Pediatric retinal photograph (wide-field): 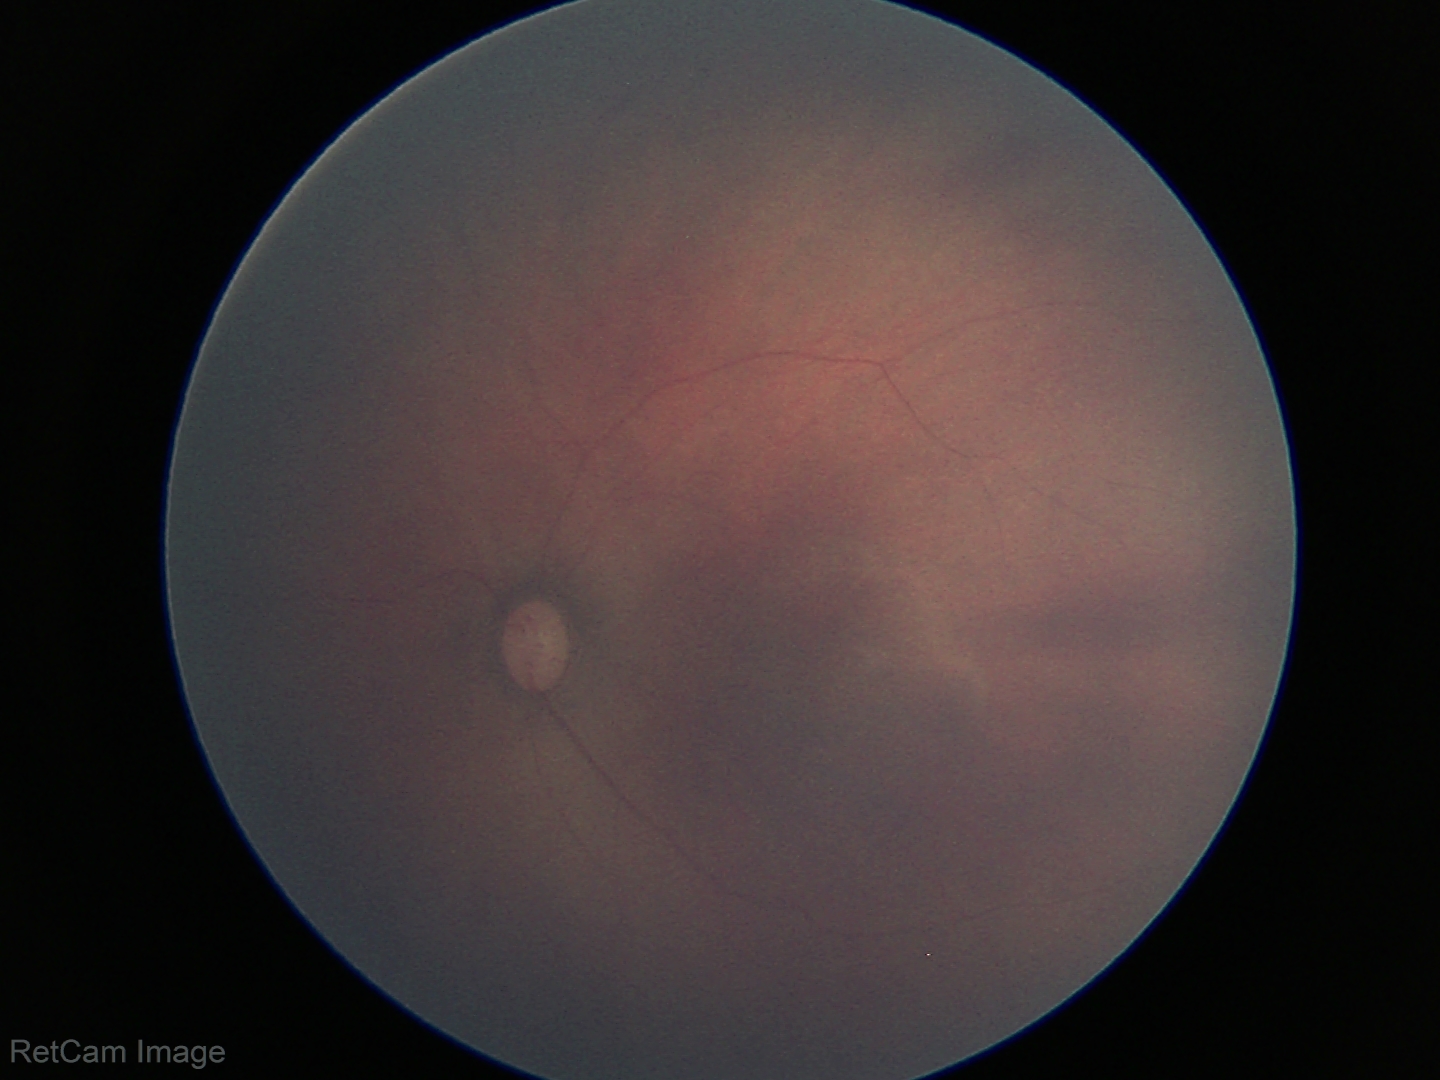 Normal screening examination.